50-degree field of view · 1924 x 1556 pixels.
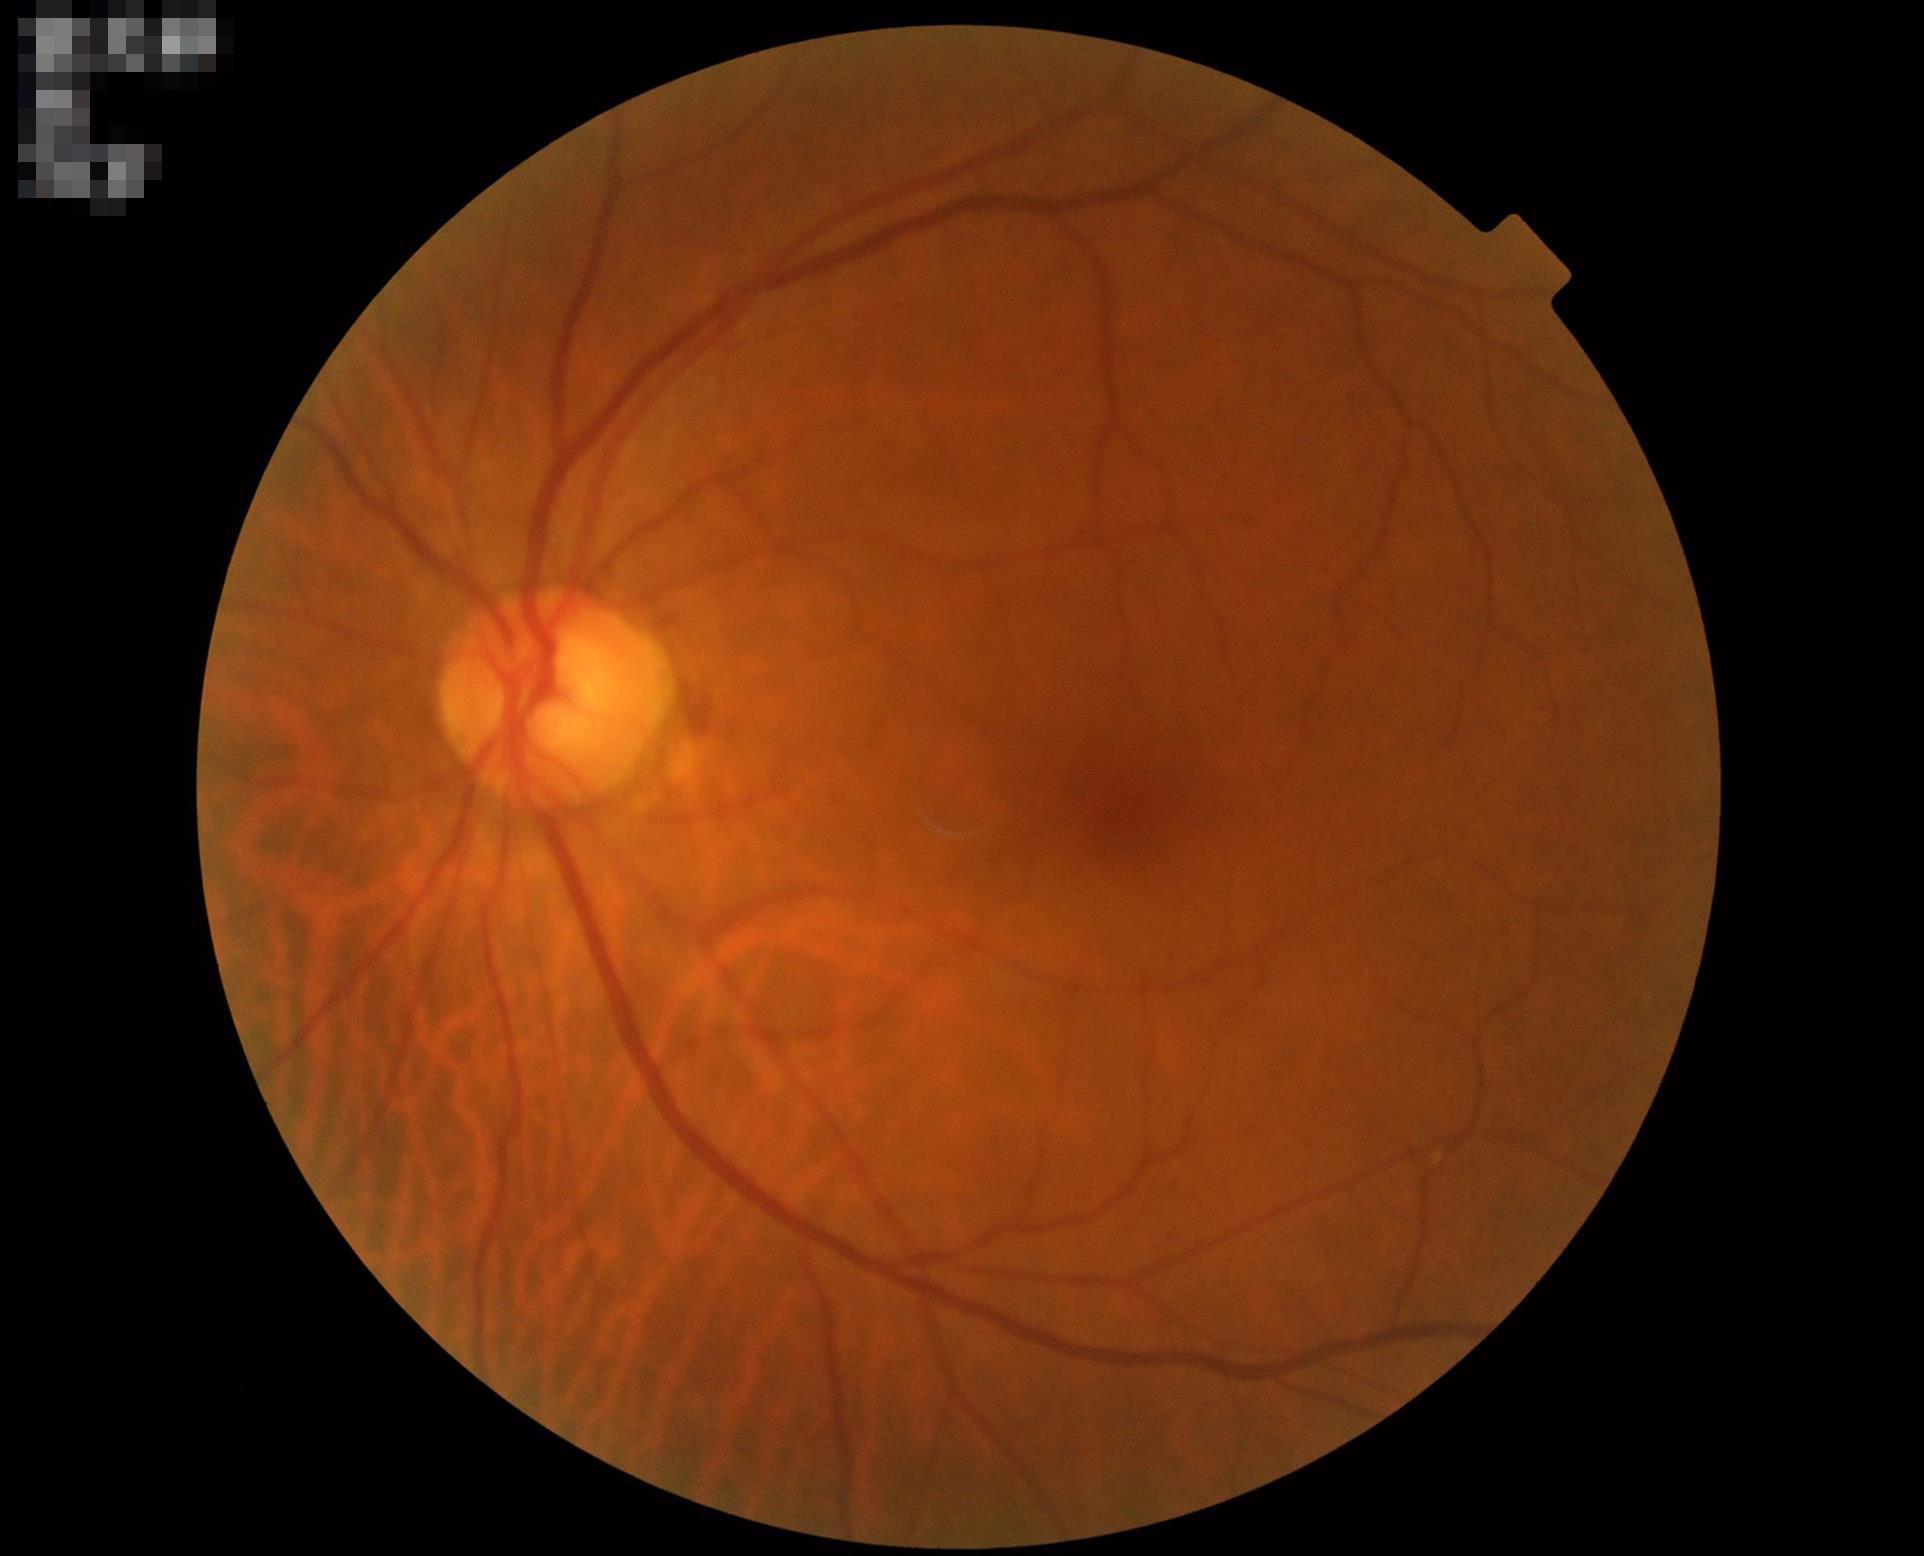 Contrast: adequate; Illumination: adequate; Clarity: in focus.